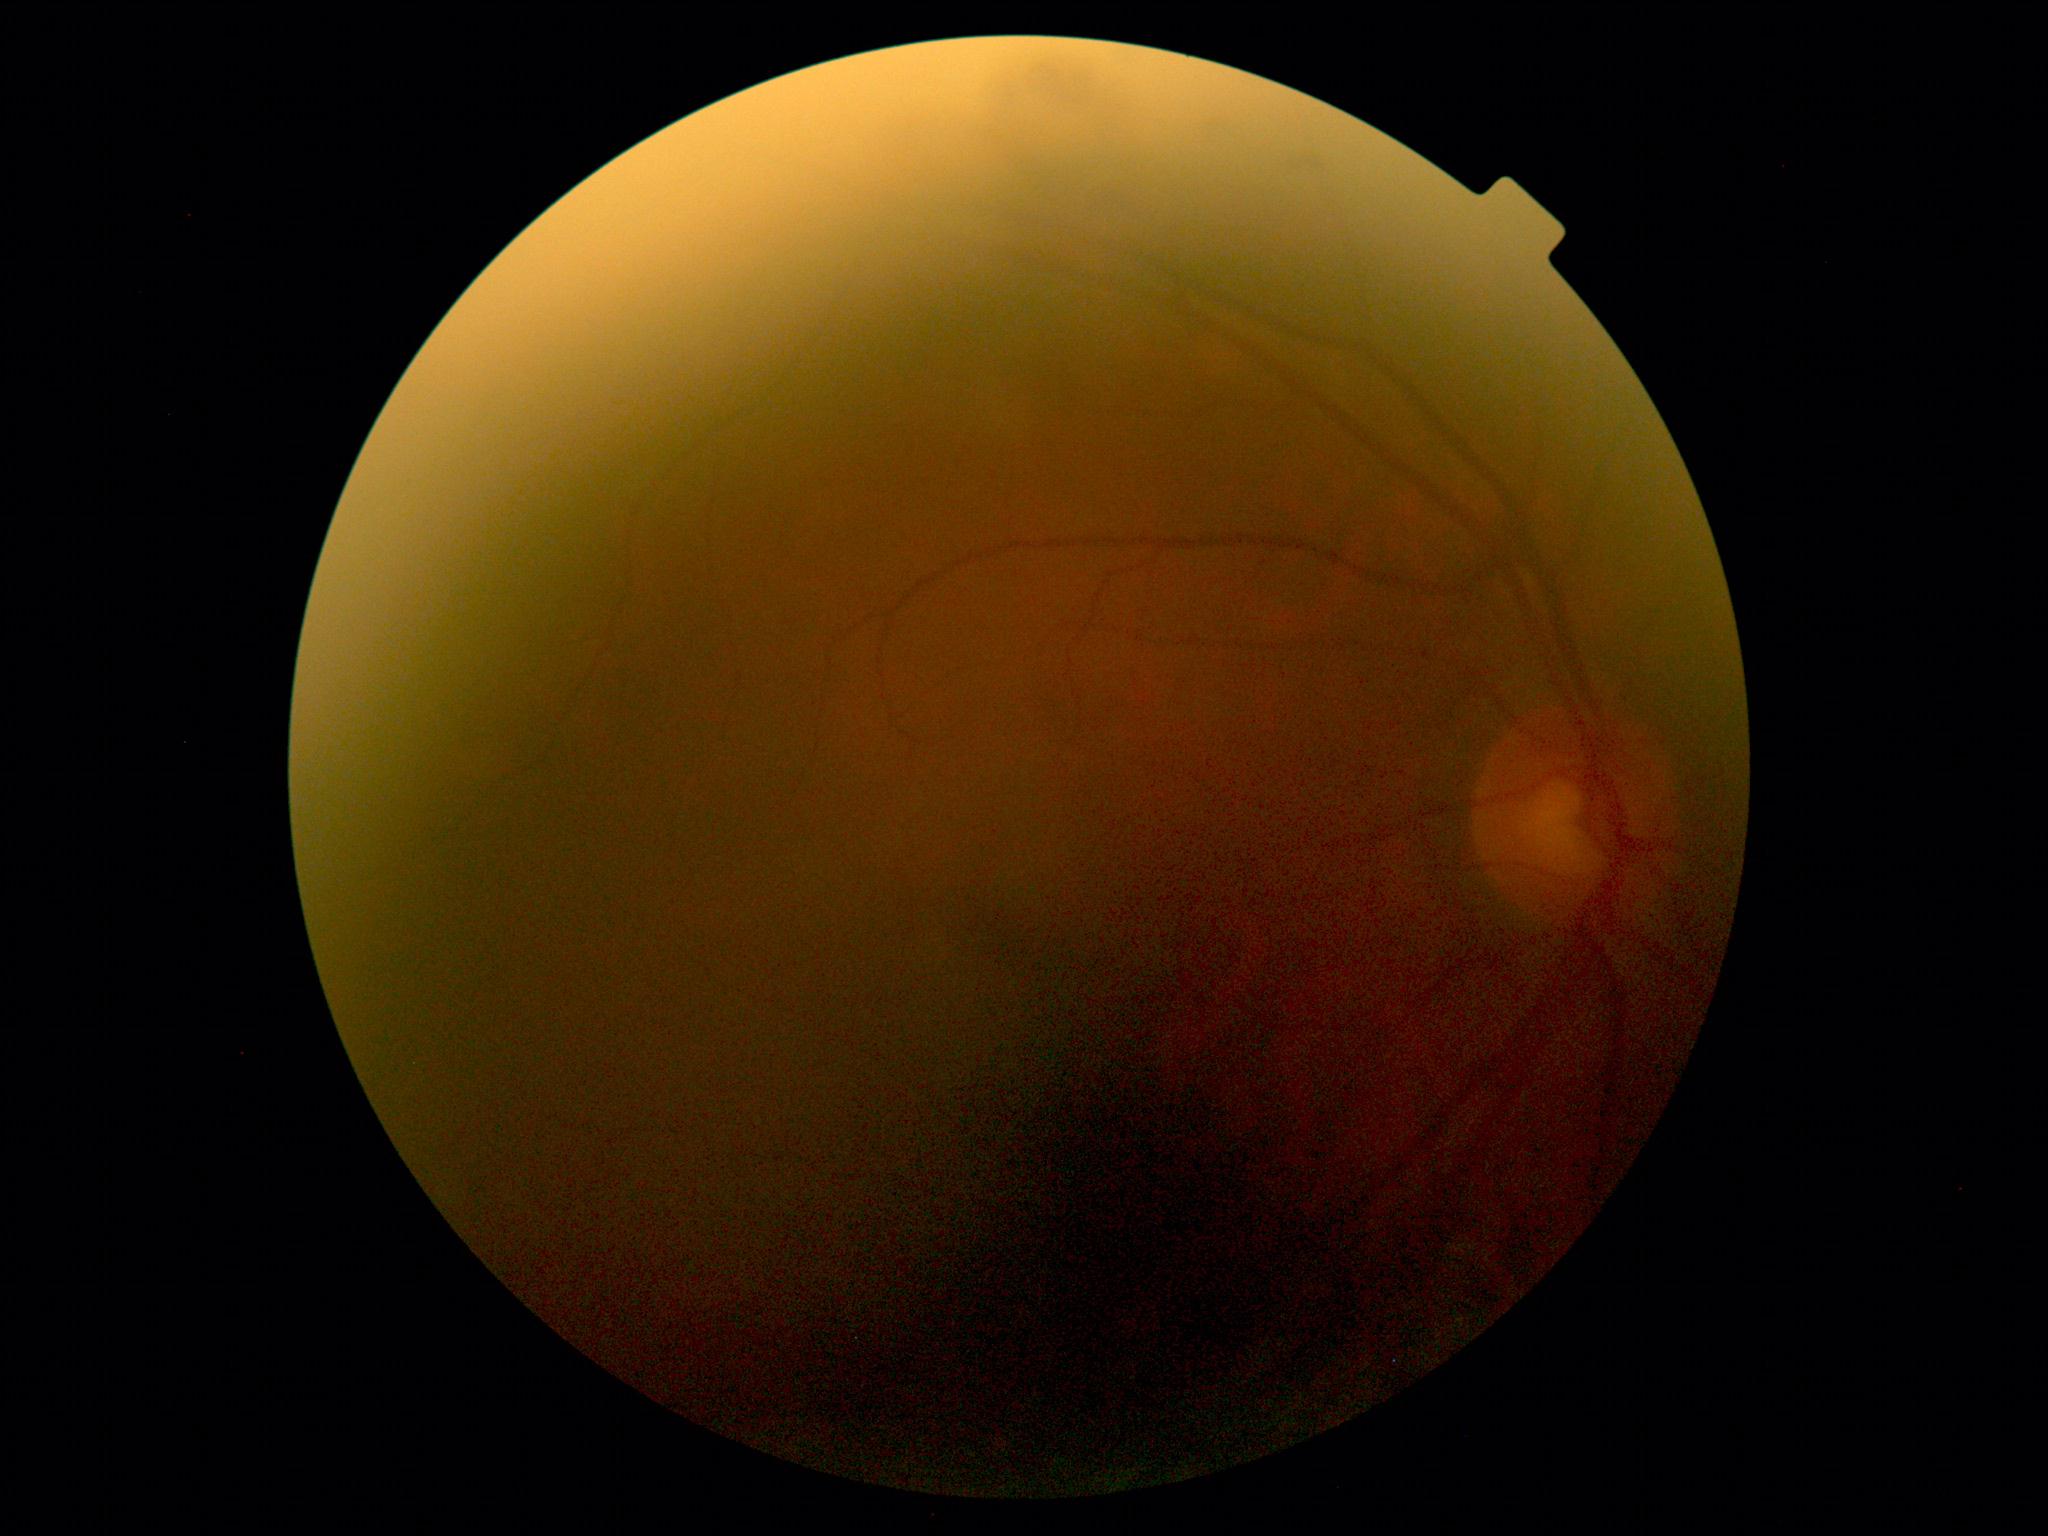   dr_grade: 0 (no apparent retinopathy)
  dr_impression: no DR findings